NIDEK AFC-230 fundus camera:
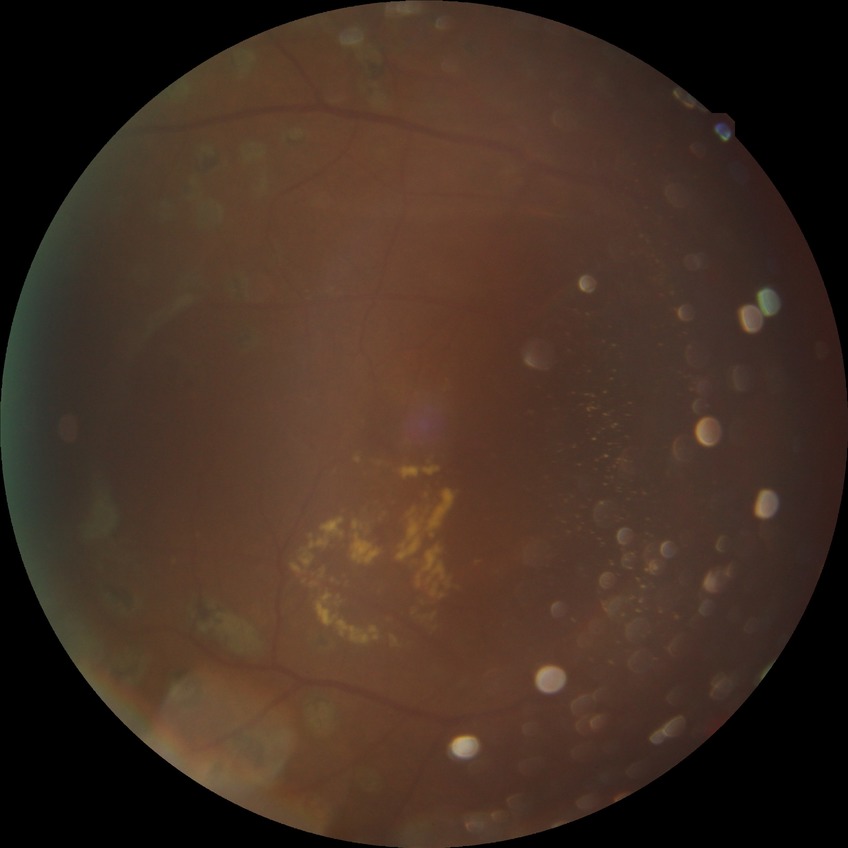

{"davis_grade": "PDR"}